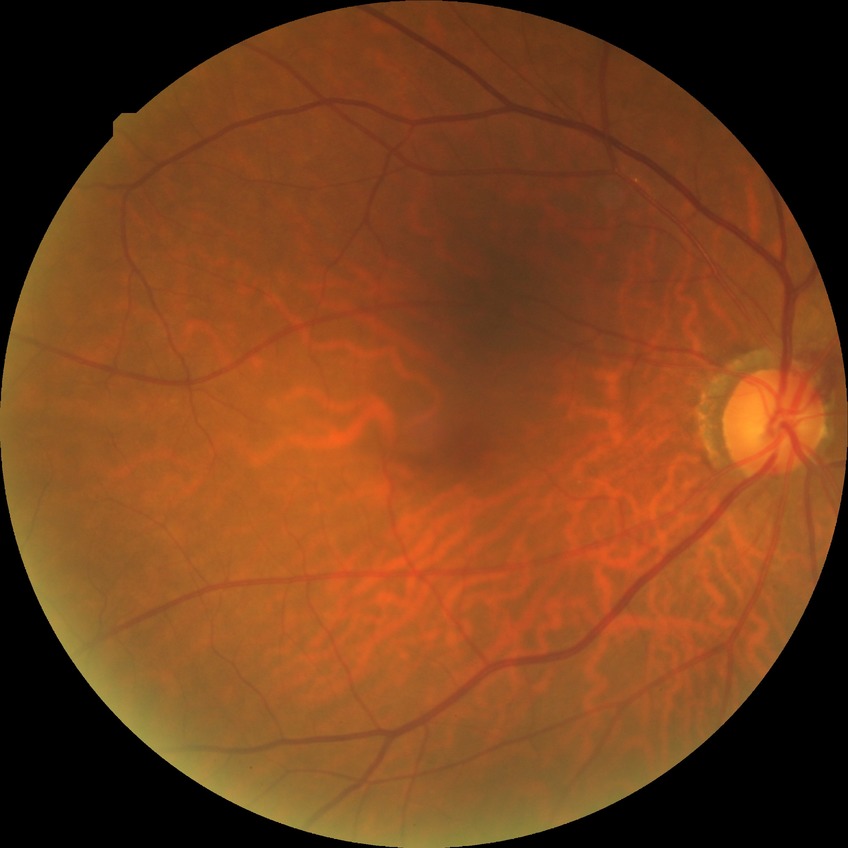 Retinopathy grade is no diabetic retinopathy.